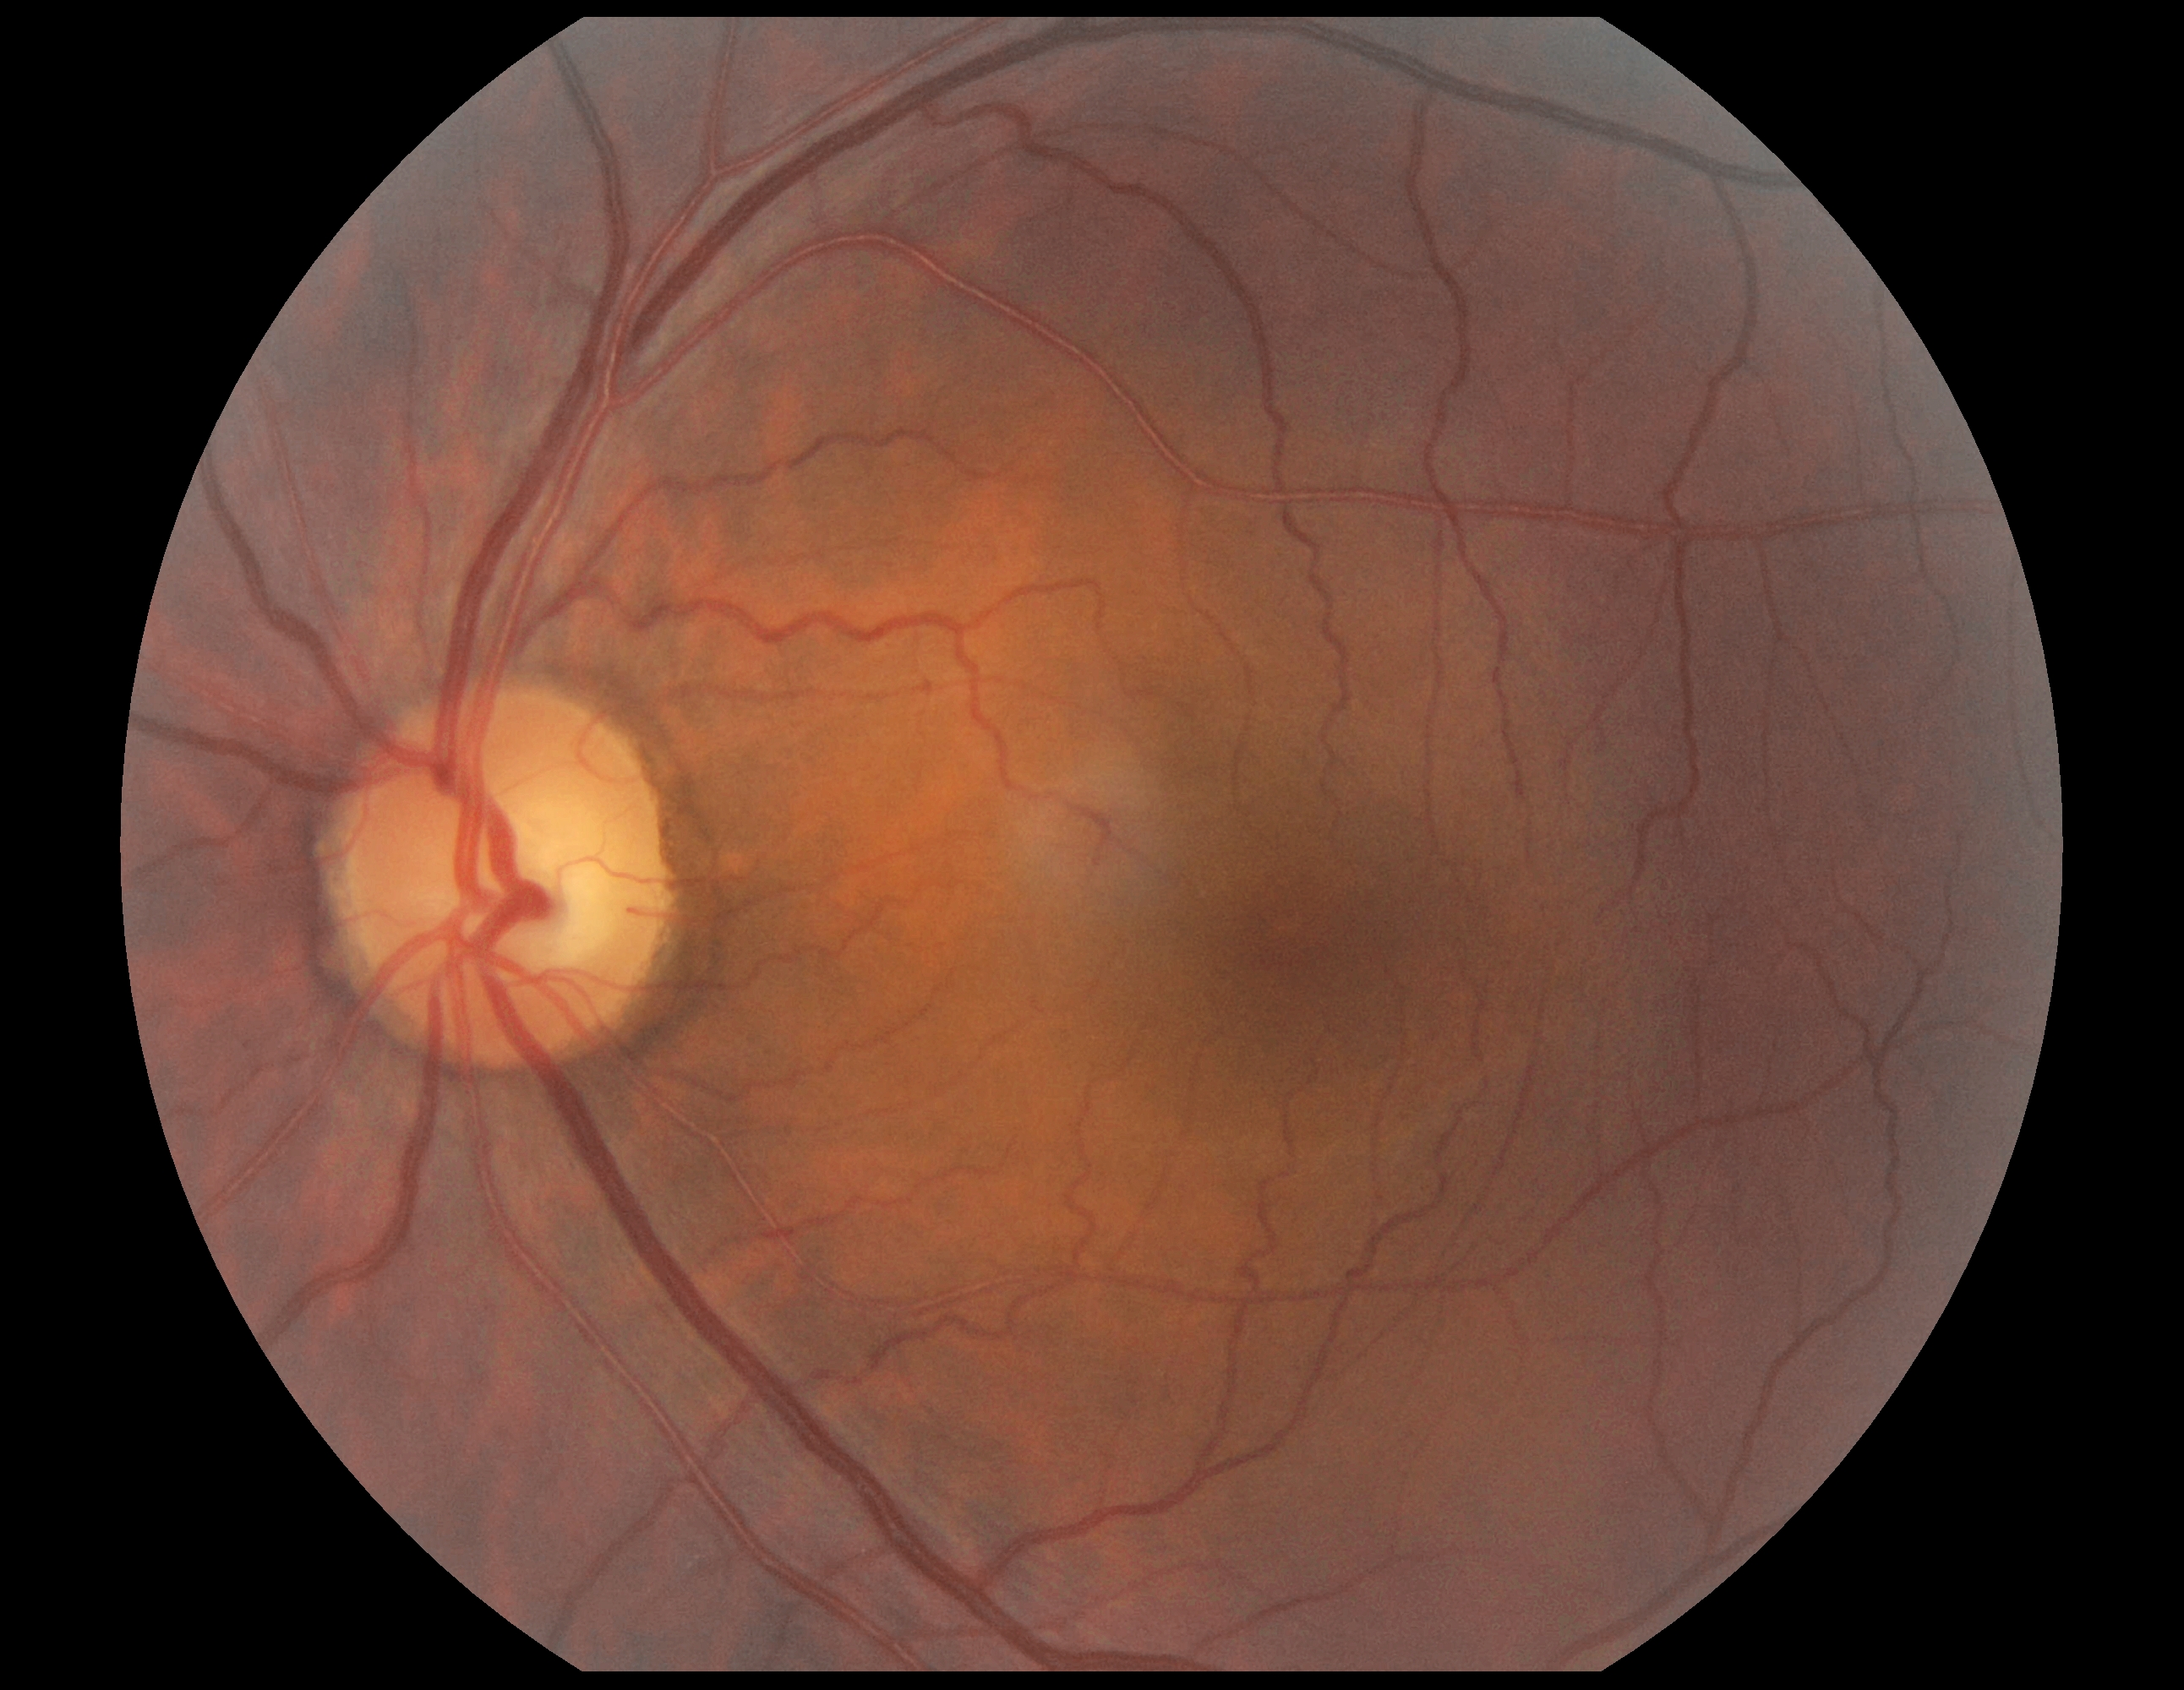

DR impression=negative for DR; diabetic retinopathy=0.